640 by 480 pixels · RetCam wide-field infant fundus image: 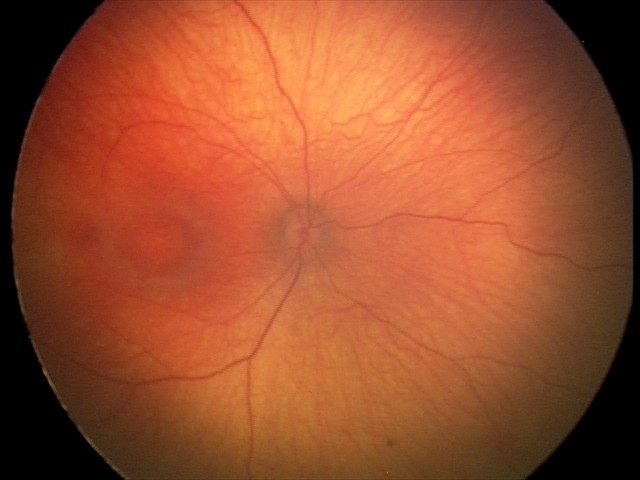 Physiological retinal appearance for postconceptual age.